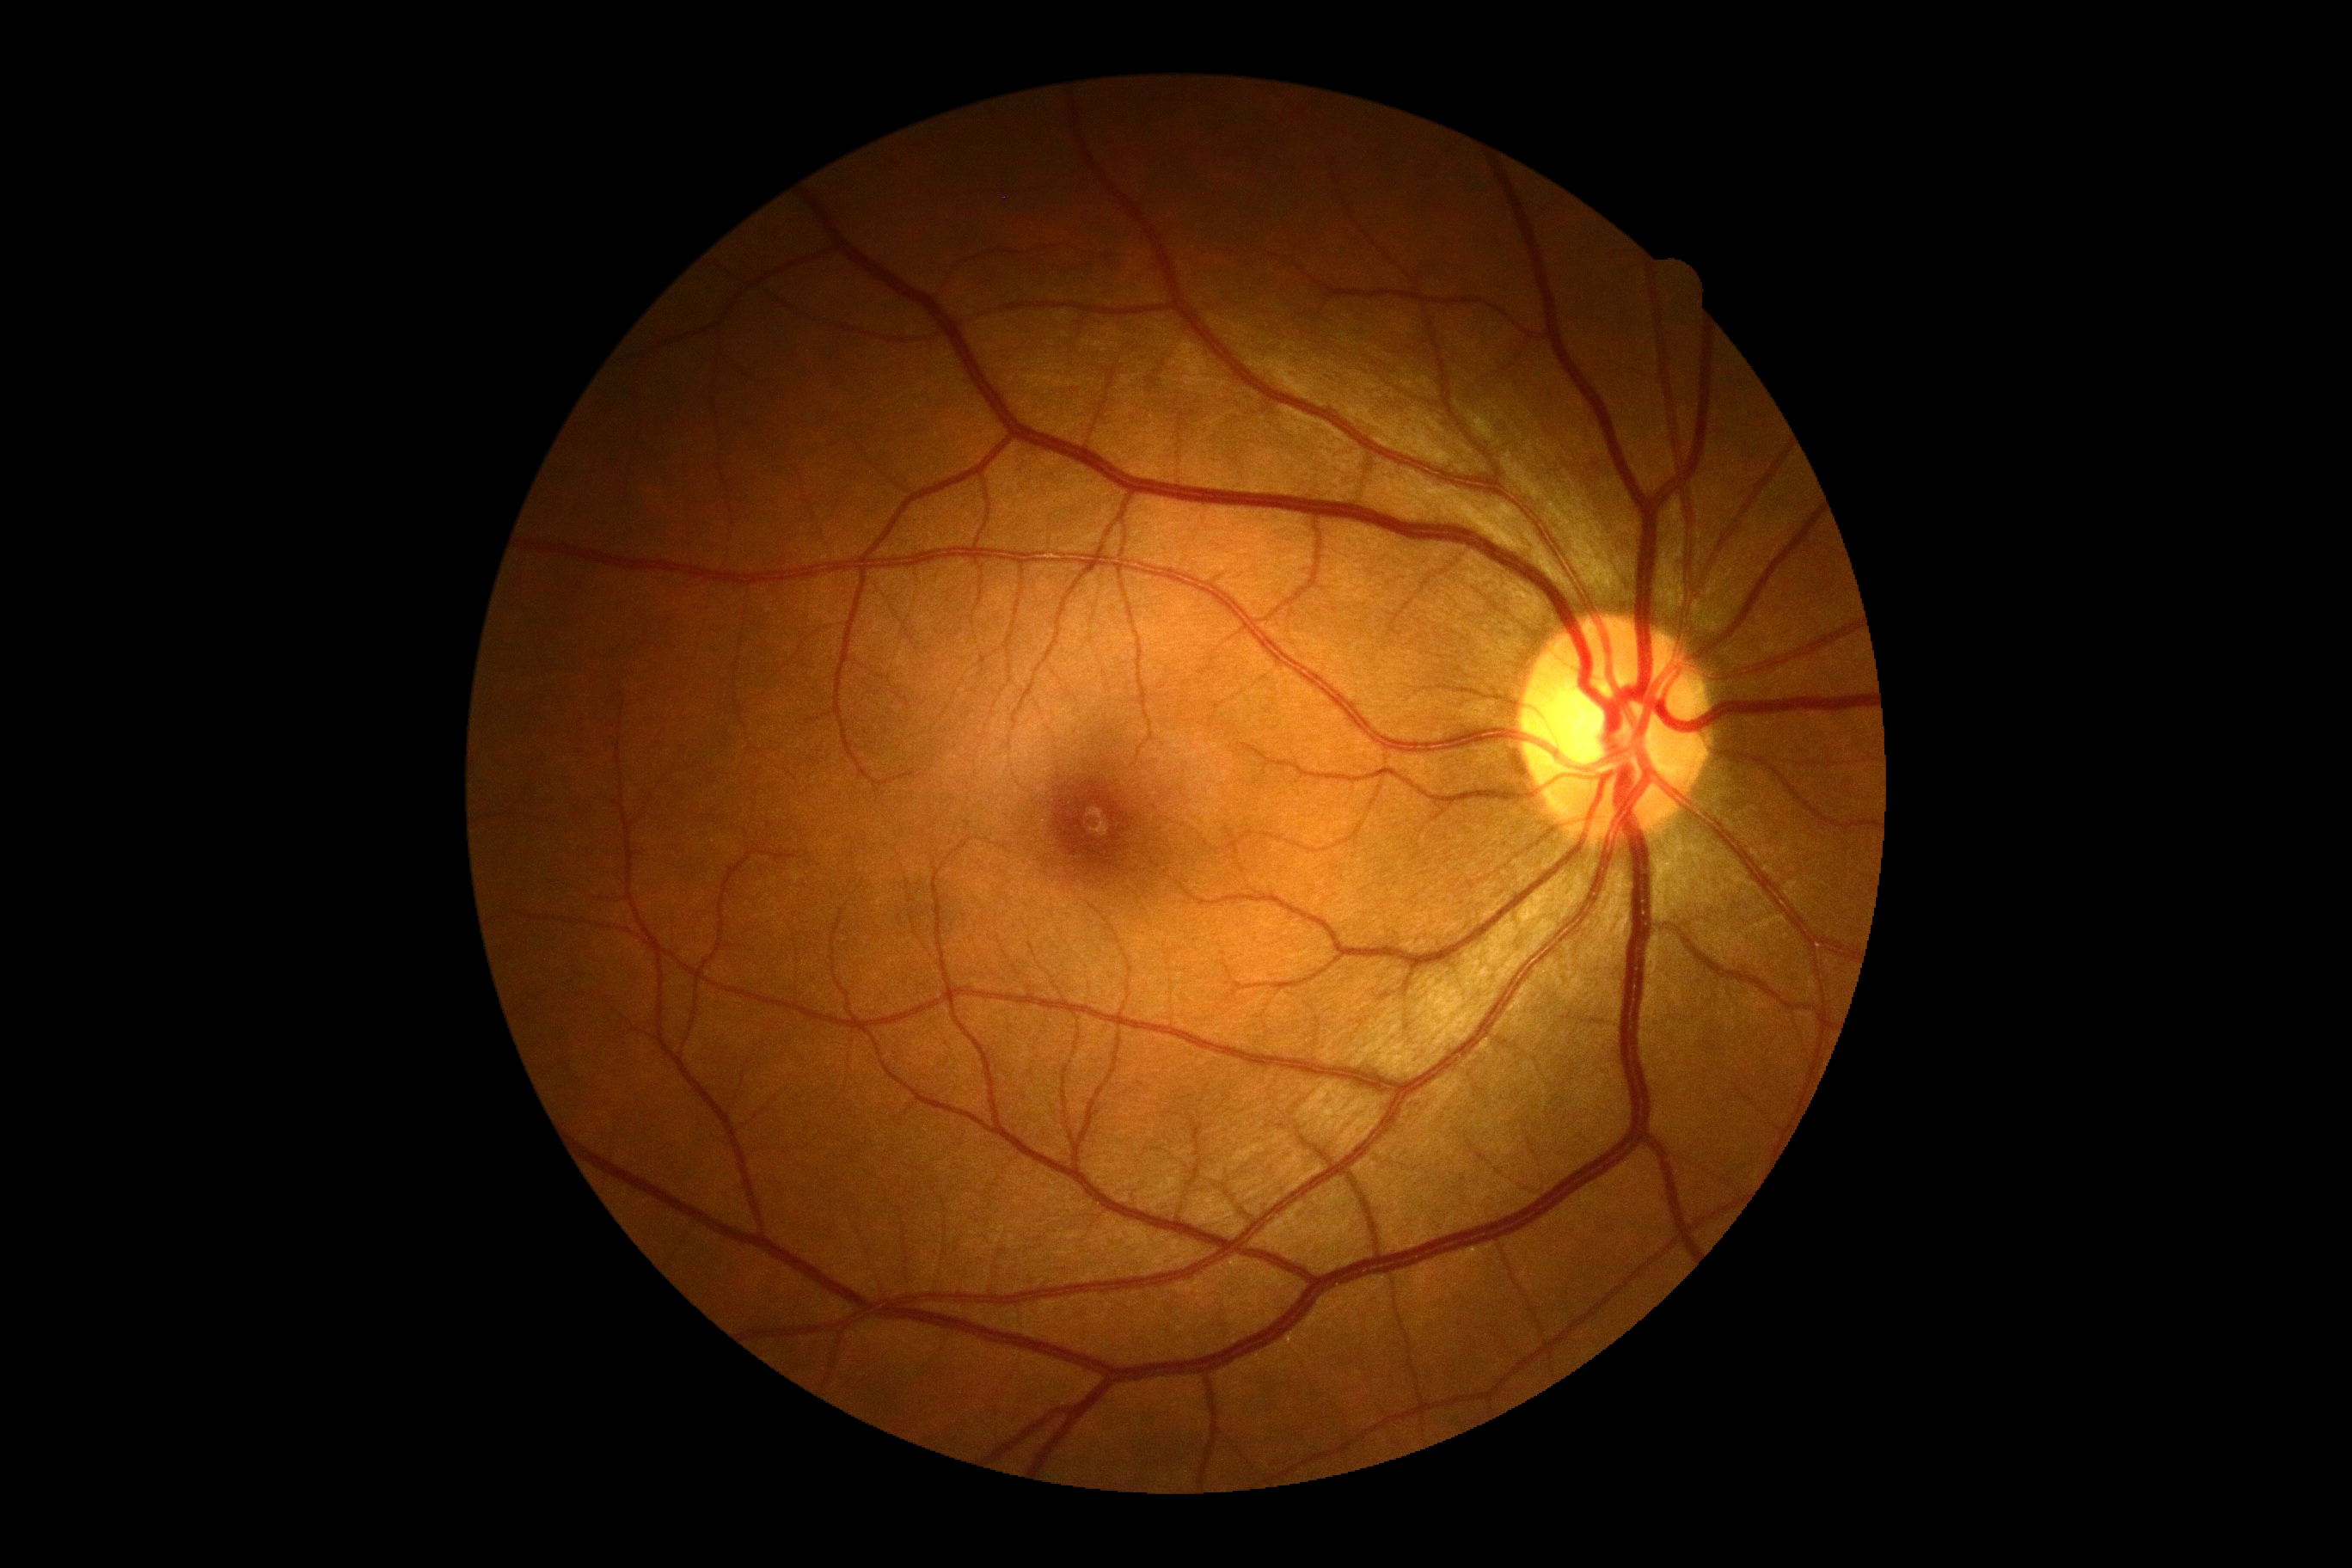

DR: 0, DR impression: no DR findings.